FOV: 45 degrees:
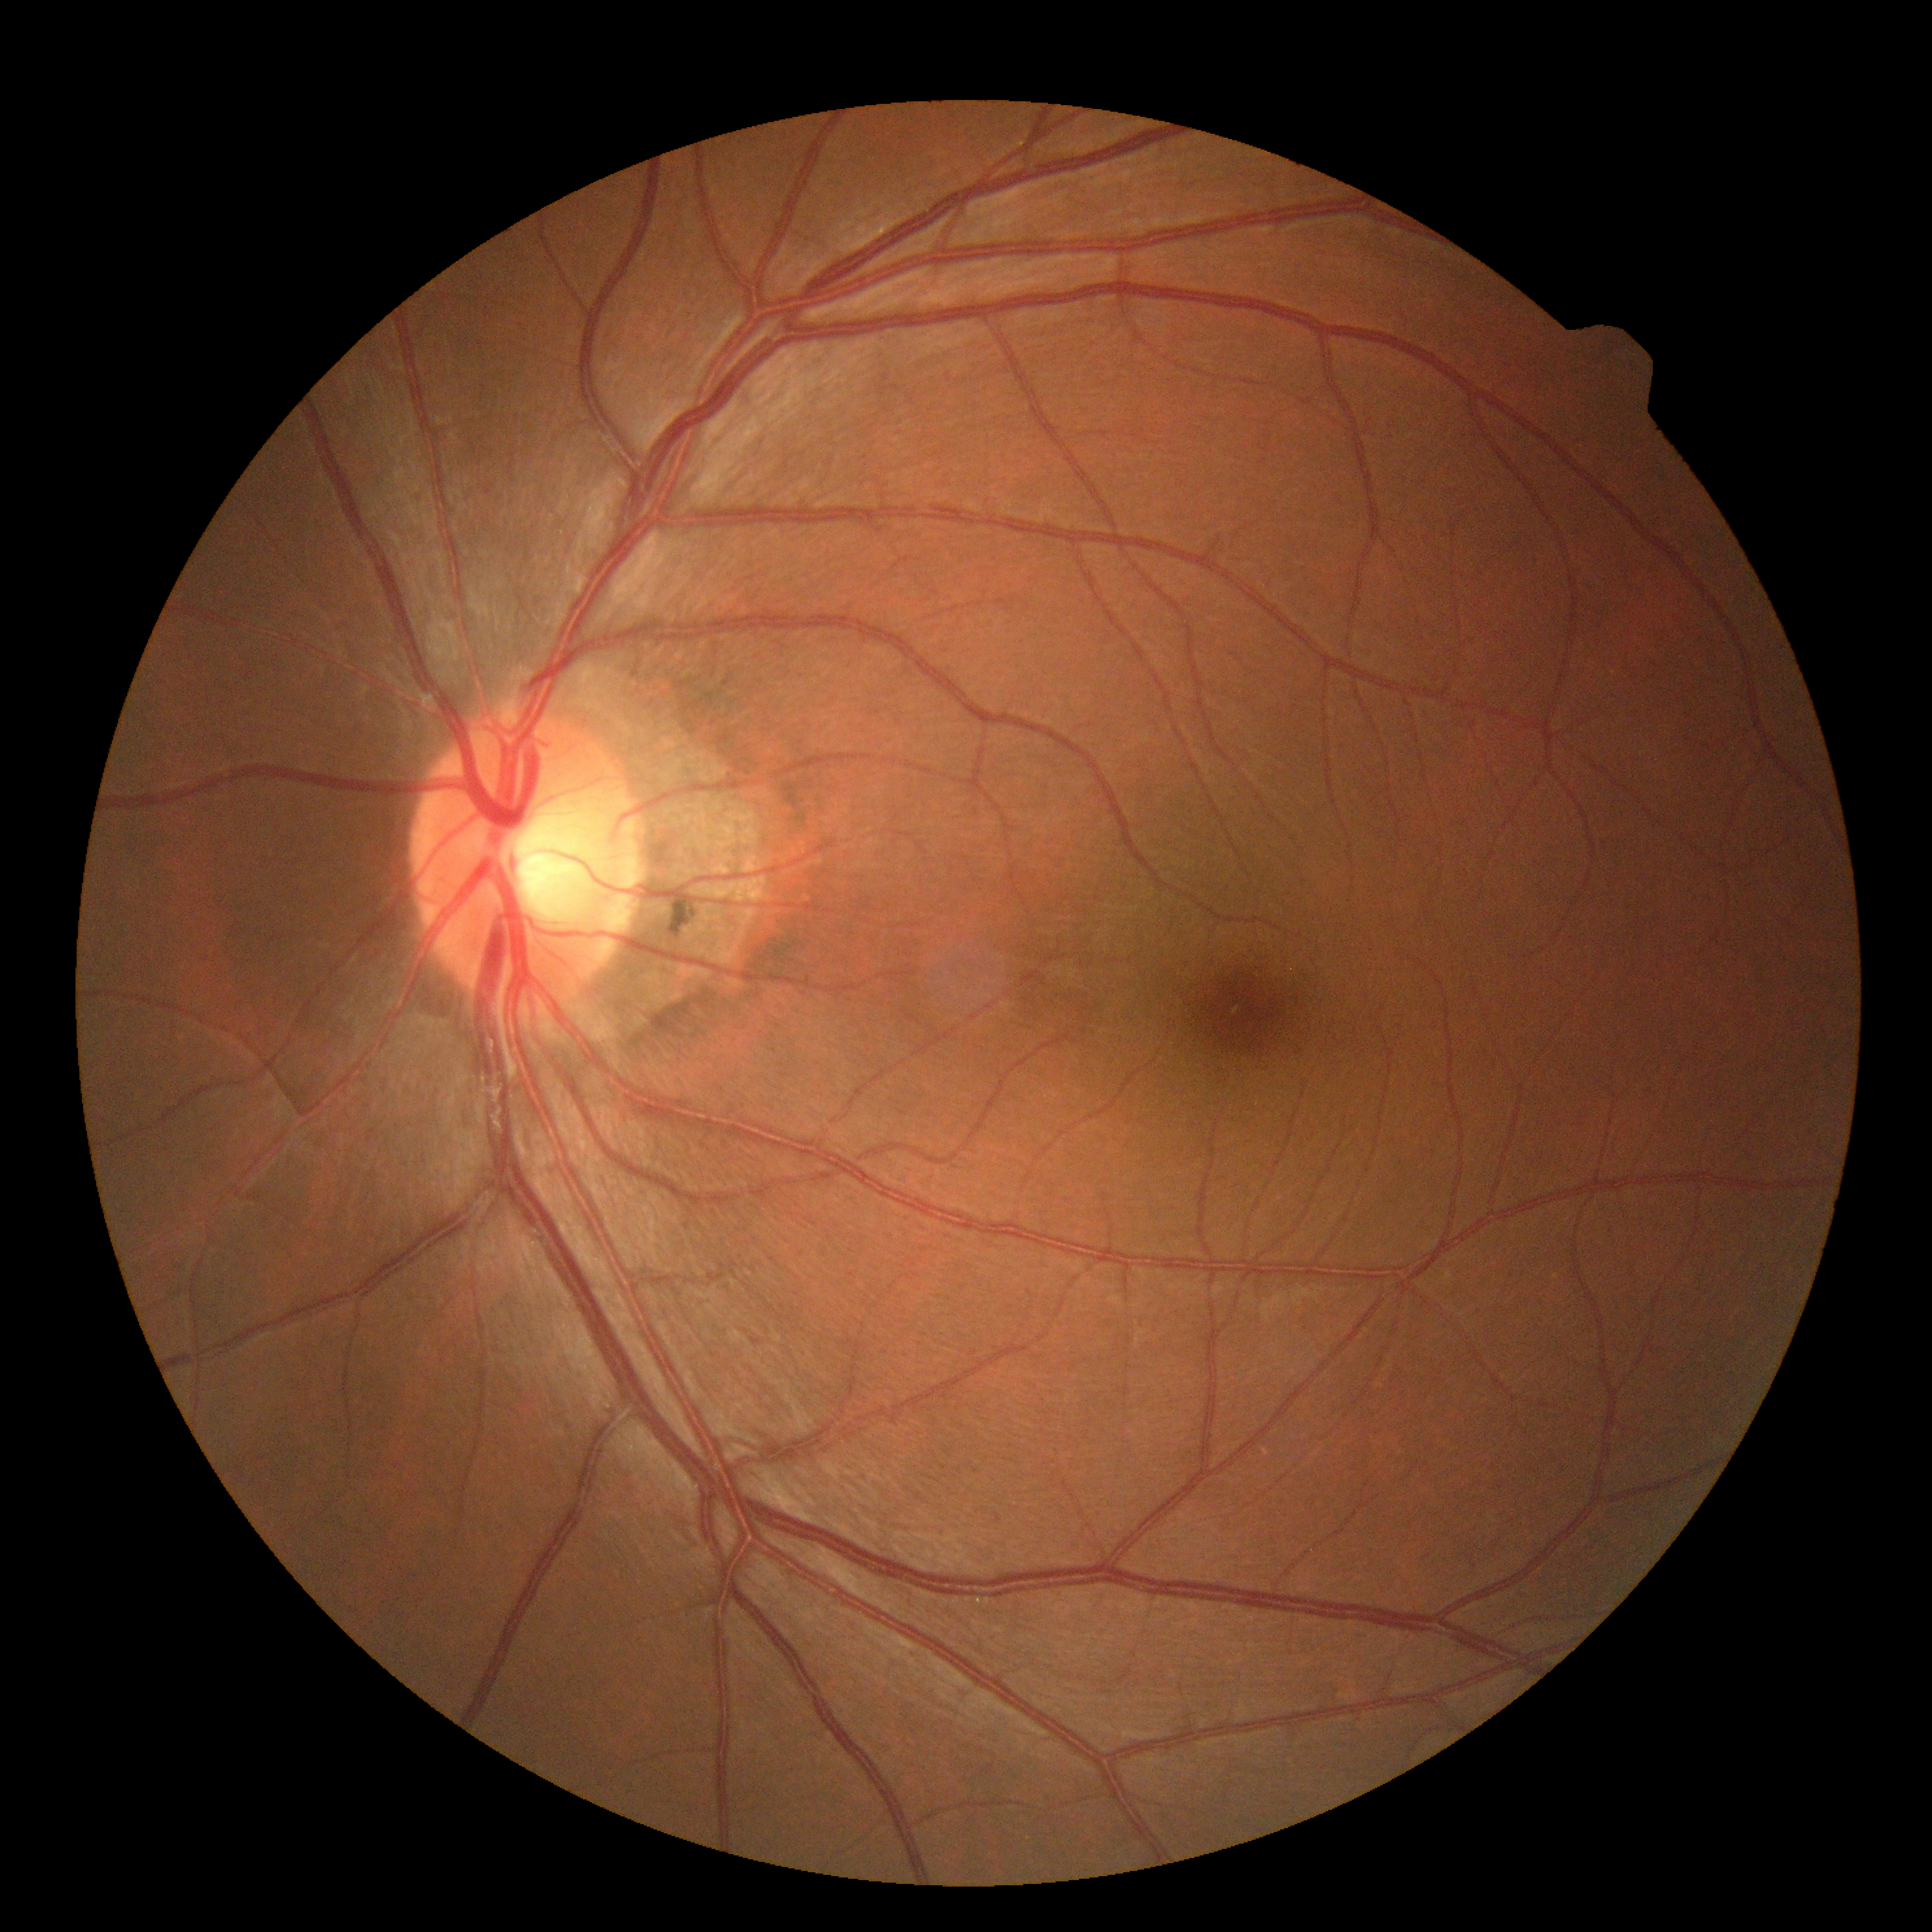
Retinopathy is 0/4.